Fundus photo
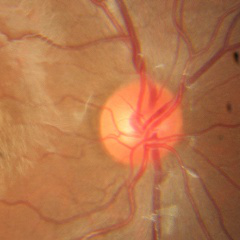

Glaucoma status: no evidence of glaucoma.